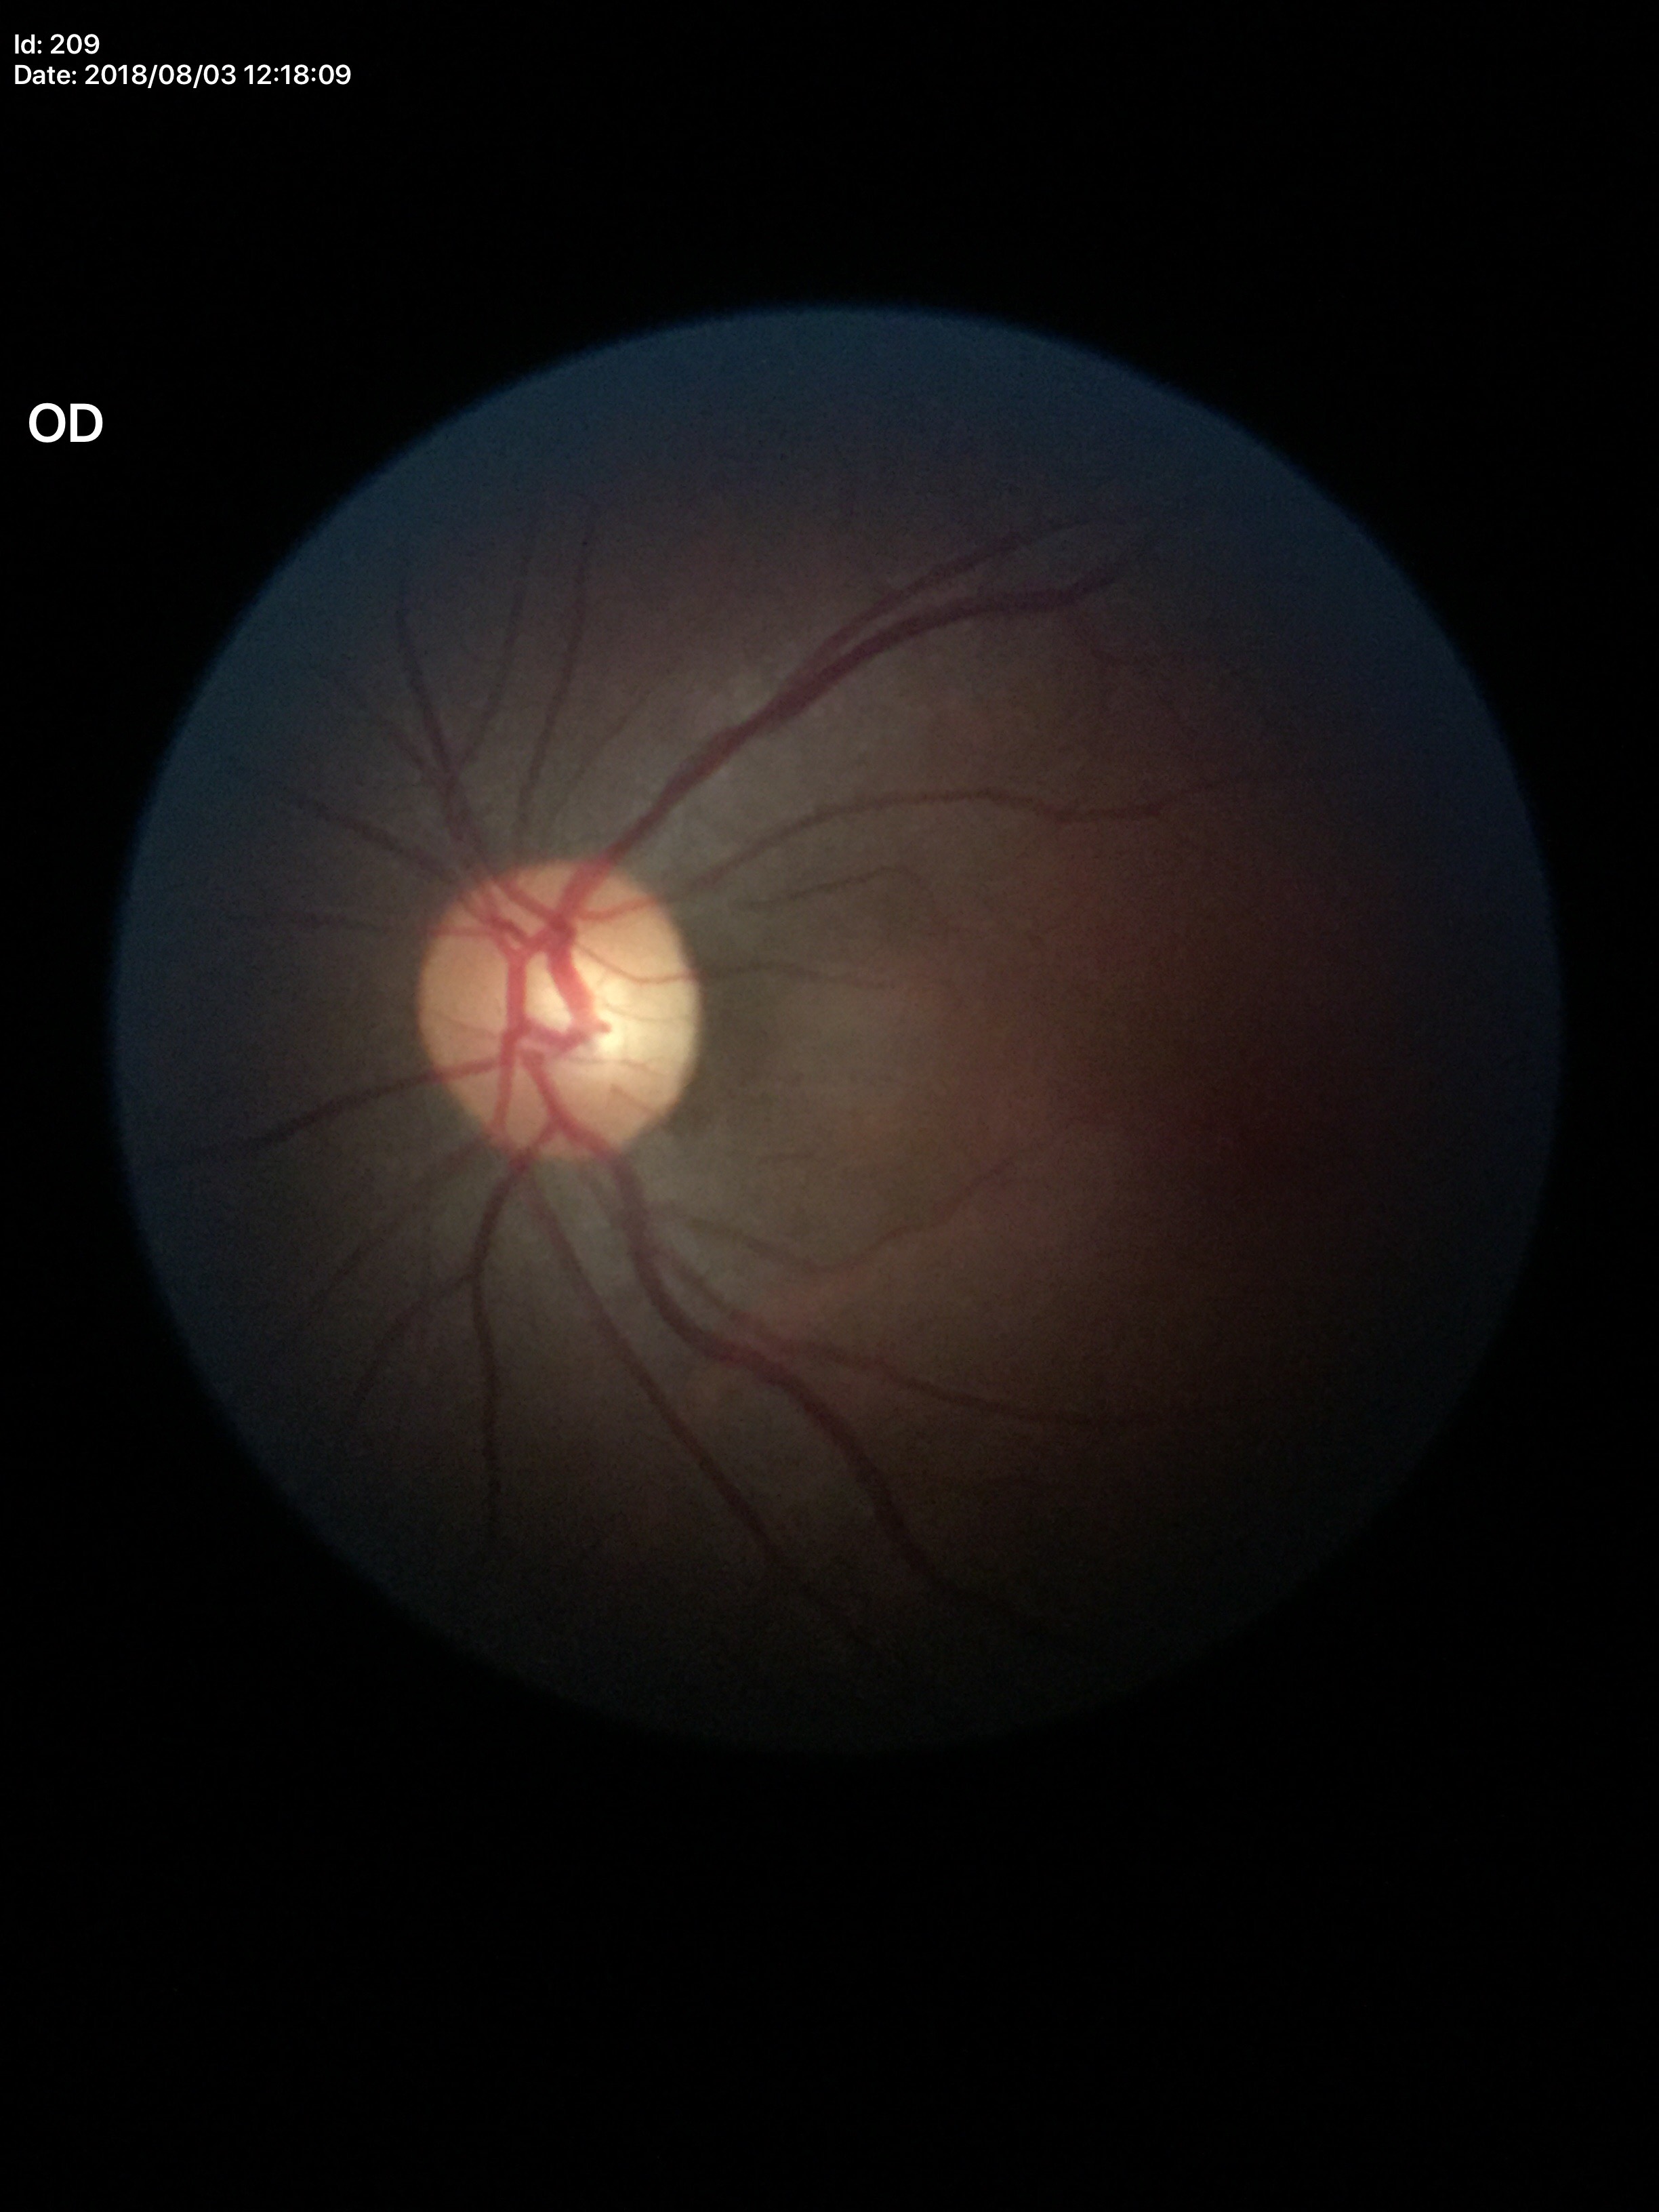 Glaucoma impression: no suspicious findings | vertical cup-to-disc ratio (VCDR): 0.52 | area CDR (ACDR): 0.28.